Modified Davis classification:
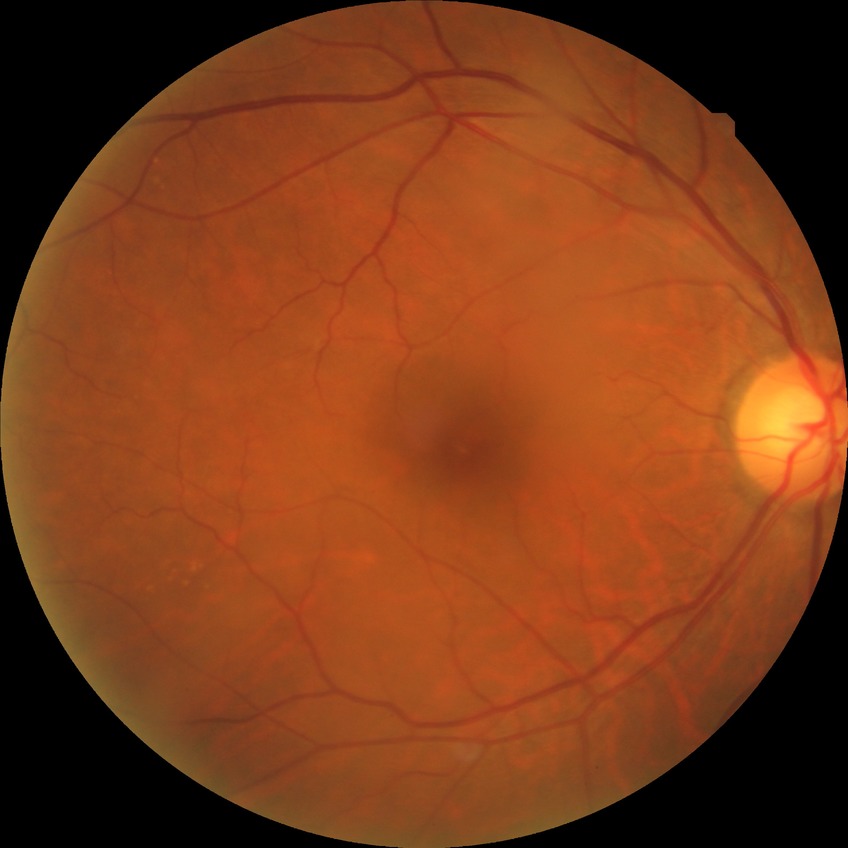
Diabetic retinopathy (DR): no diabetic retinopathy (NDR).